Modified Davis grading — 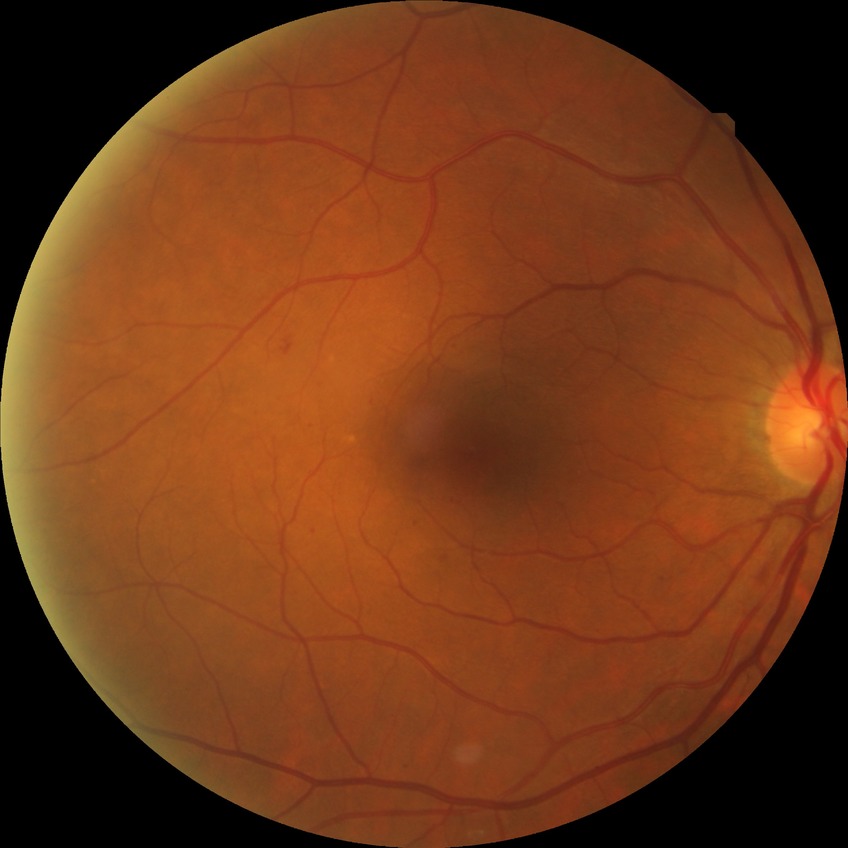
The retinopathy is classified as non-proliferative diabetic retinopathy. Diabetic retinopathy (DR) is simple diabetic retinopathy (SDR).